45-degree field of view
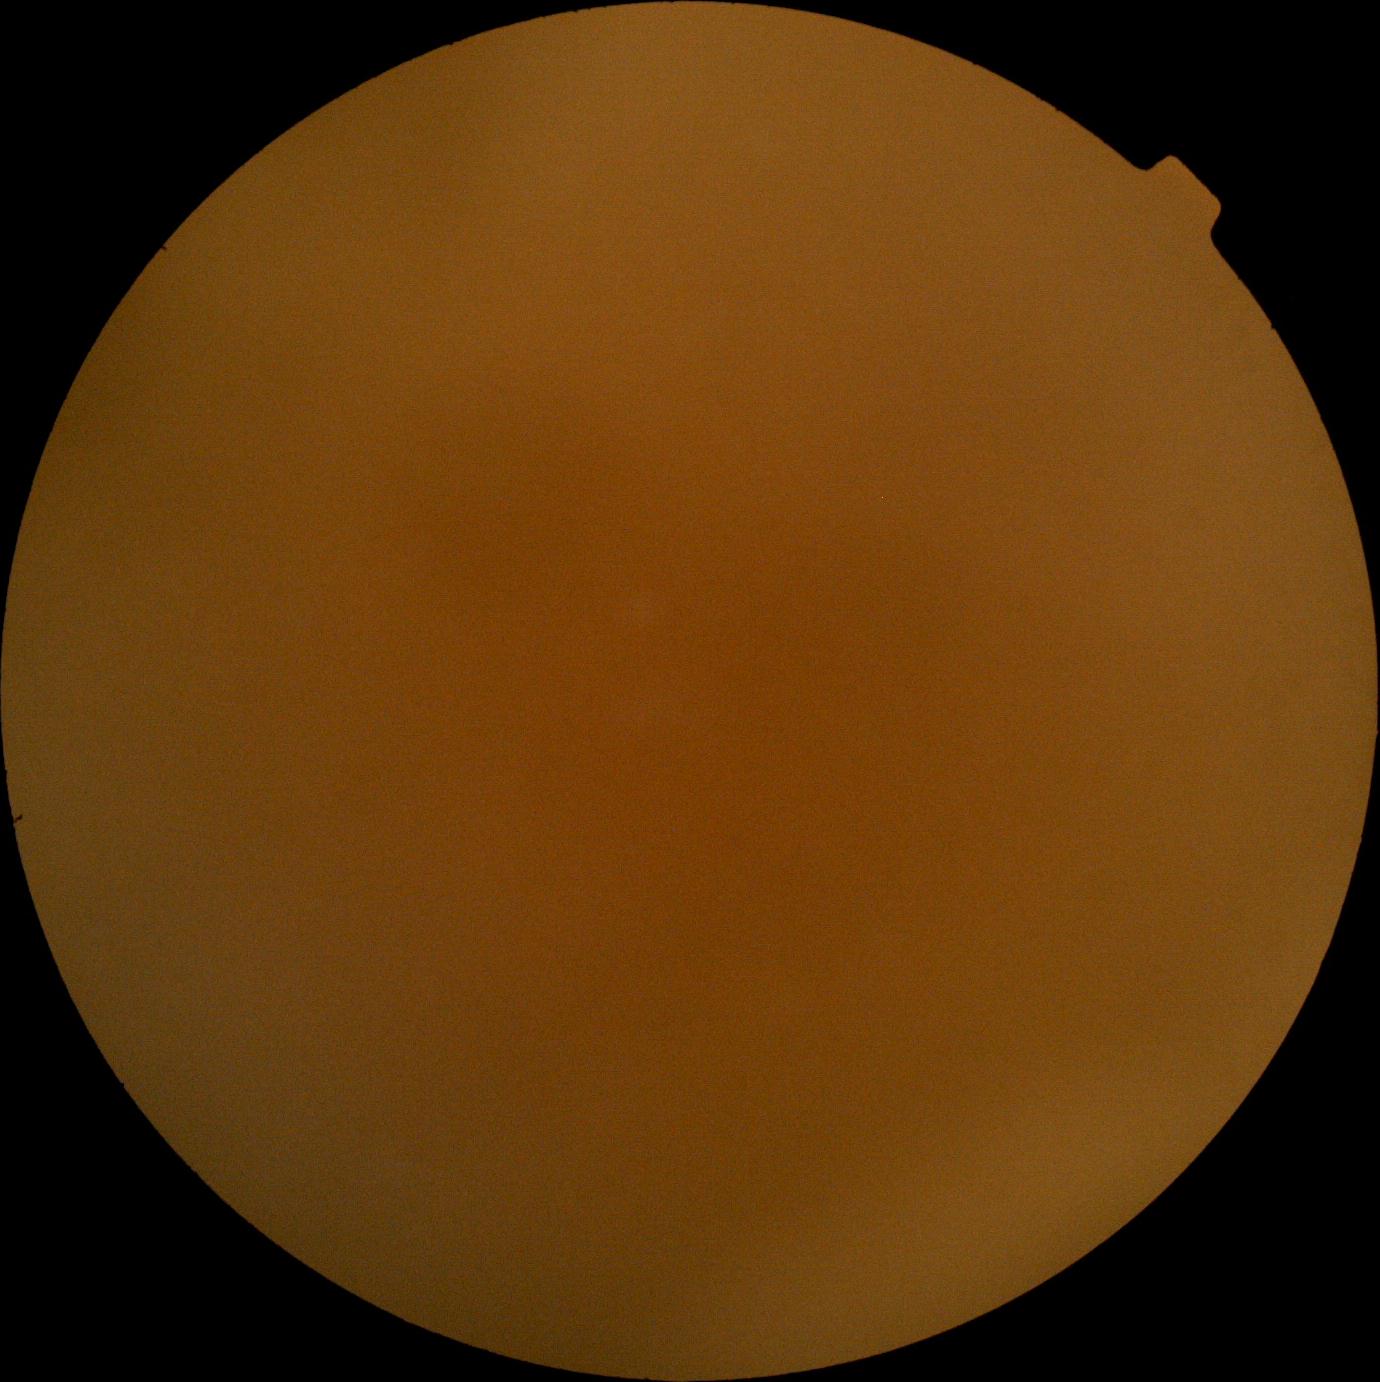 {"dr_grade": "ungradable due to poor image quality", "quality": "too poor for DR grading"}